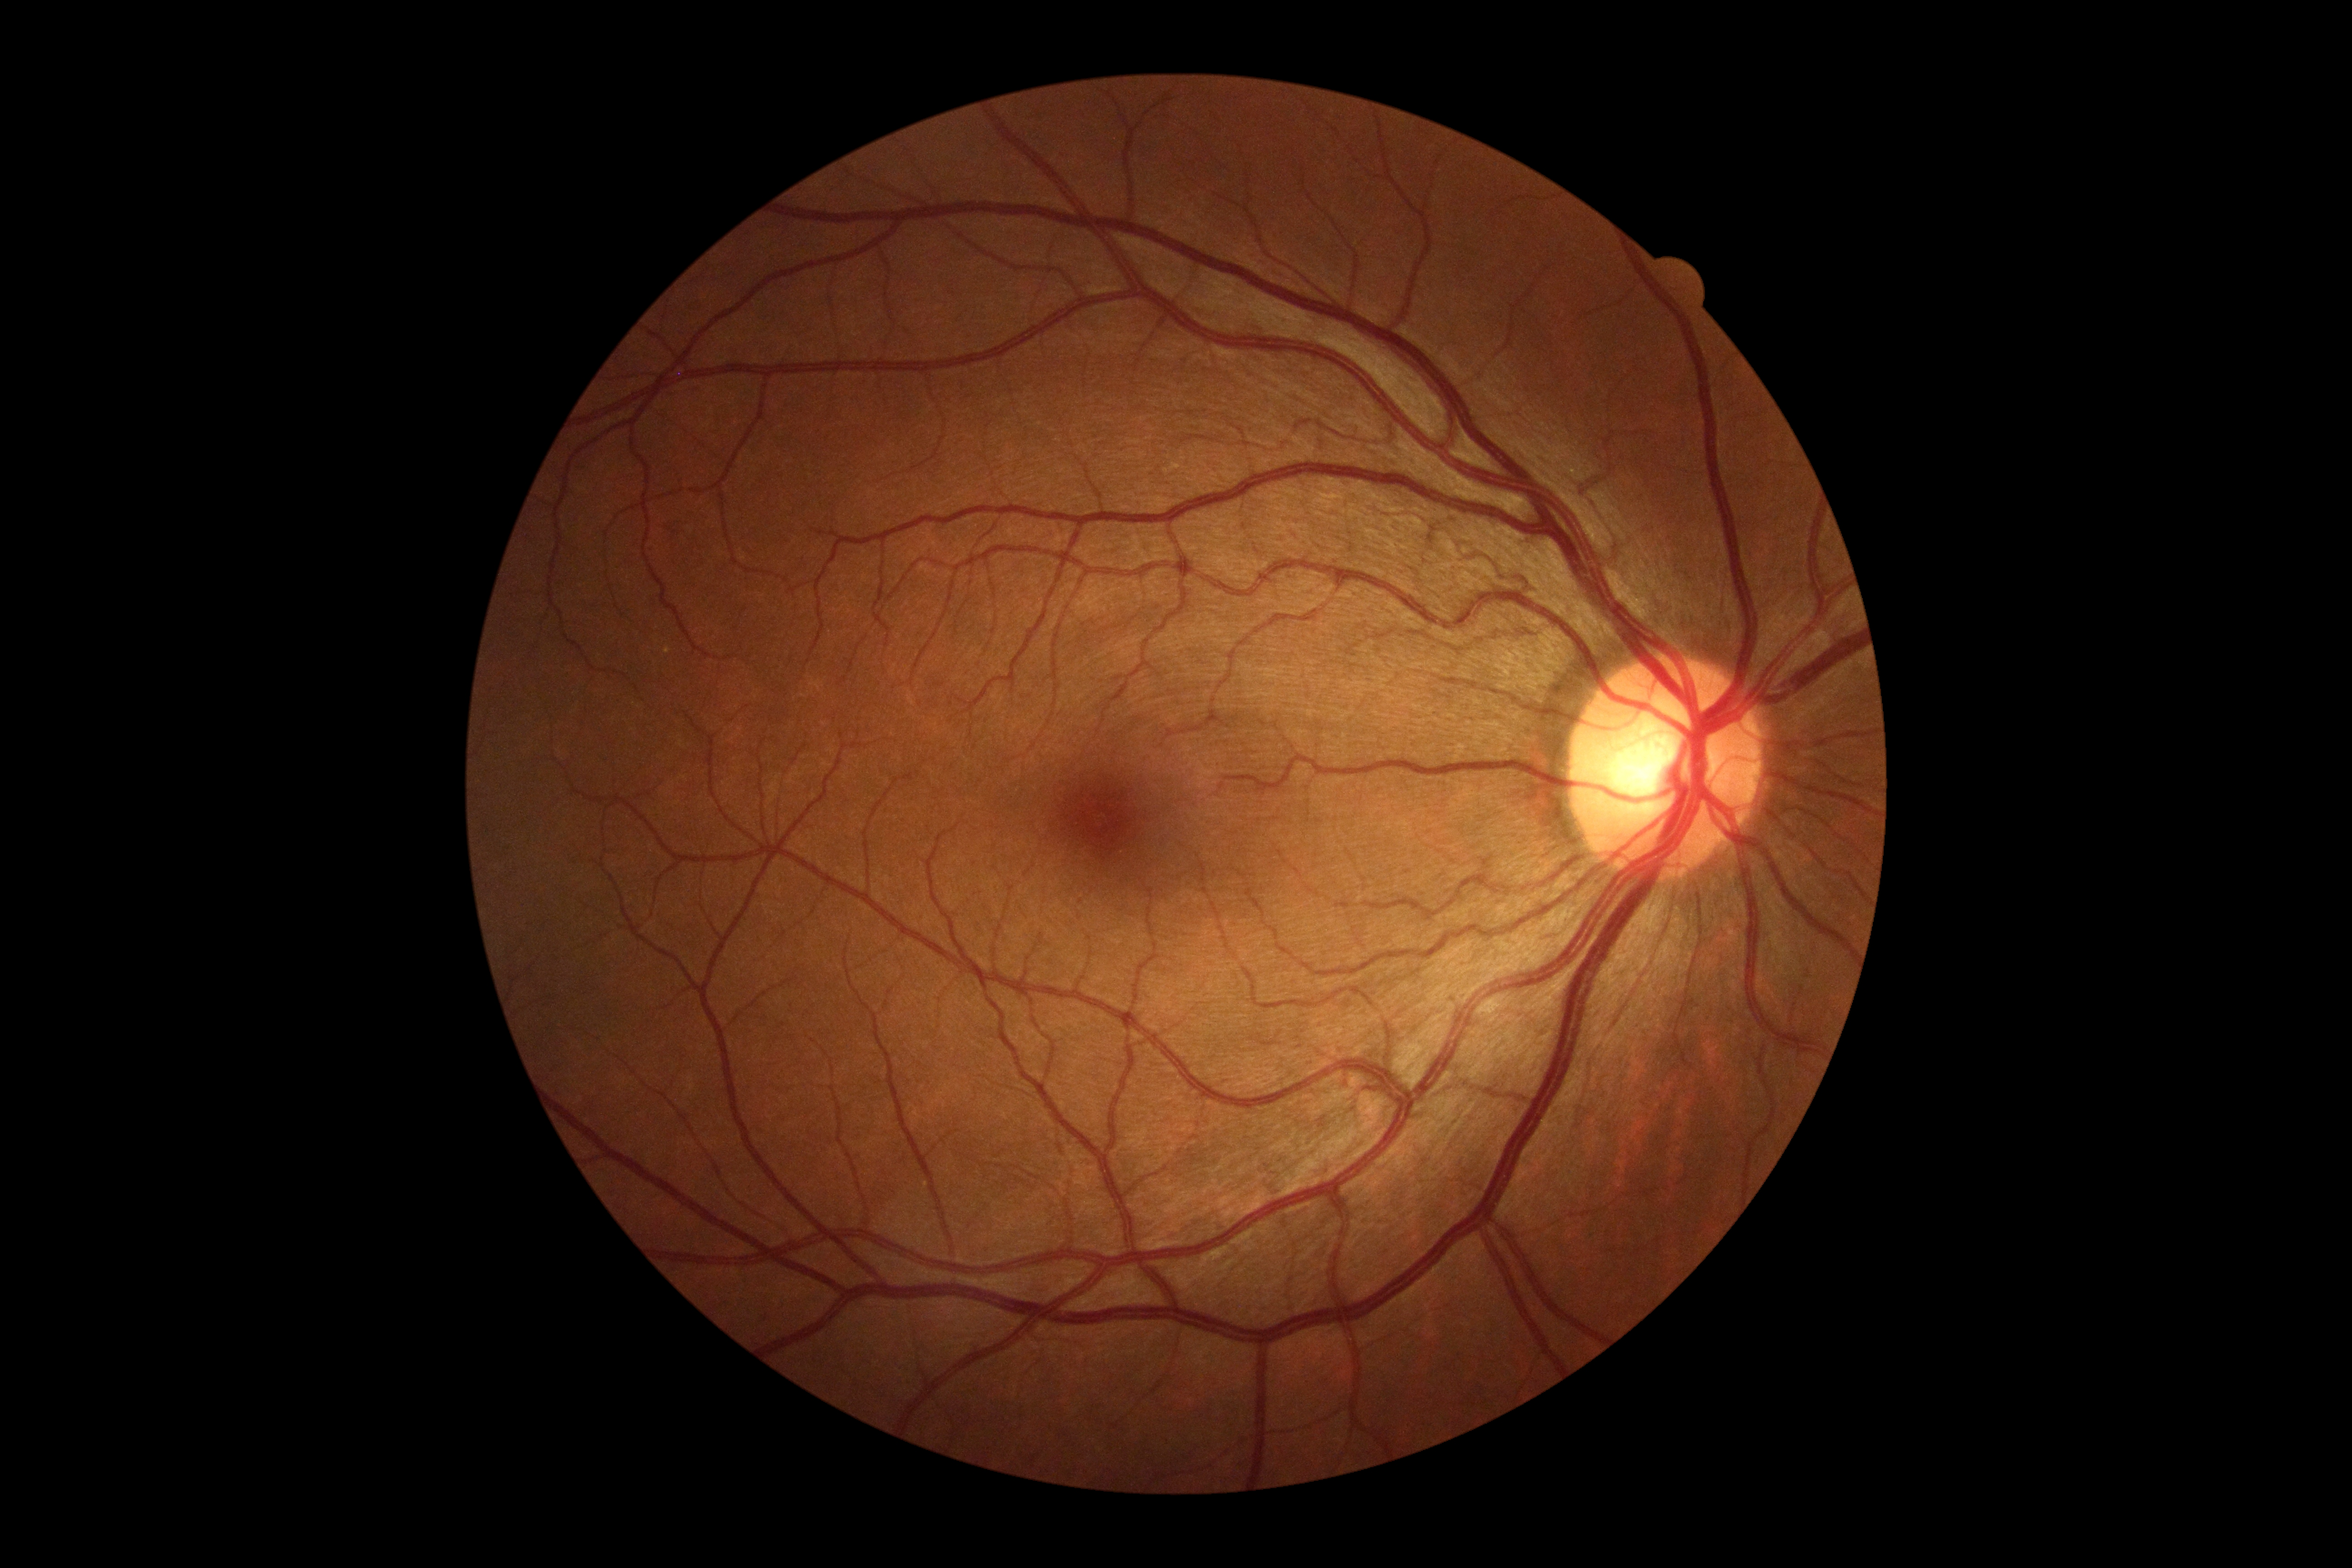

Diabetic retinopathy: no apparent retinopathy (grade 0).